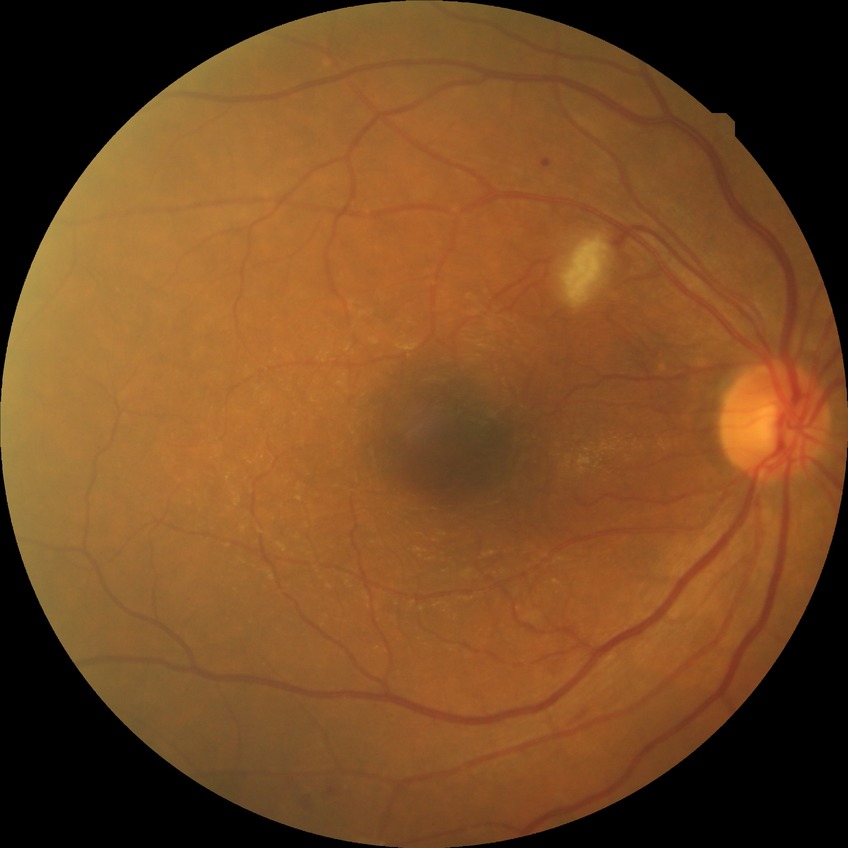

diabetic retinopathy (DR): no diabetic retinopathy (NDR)